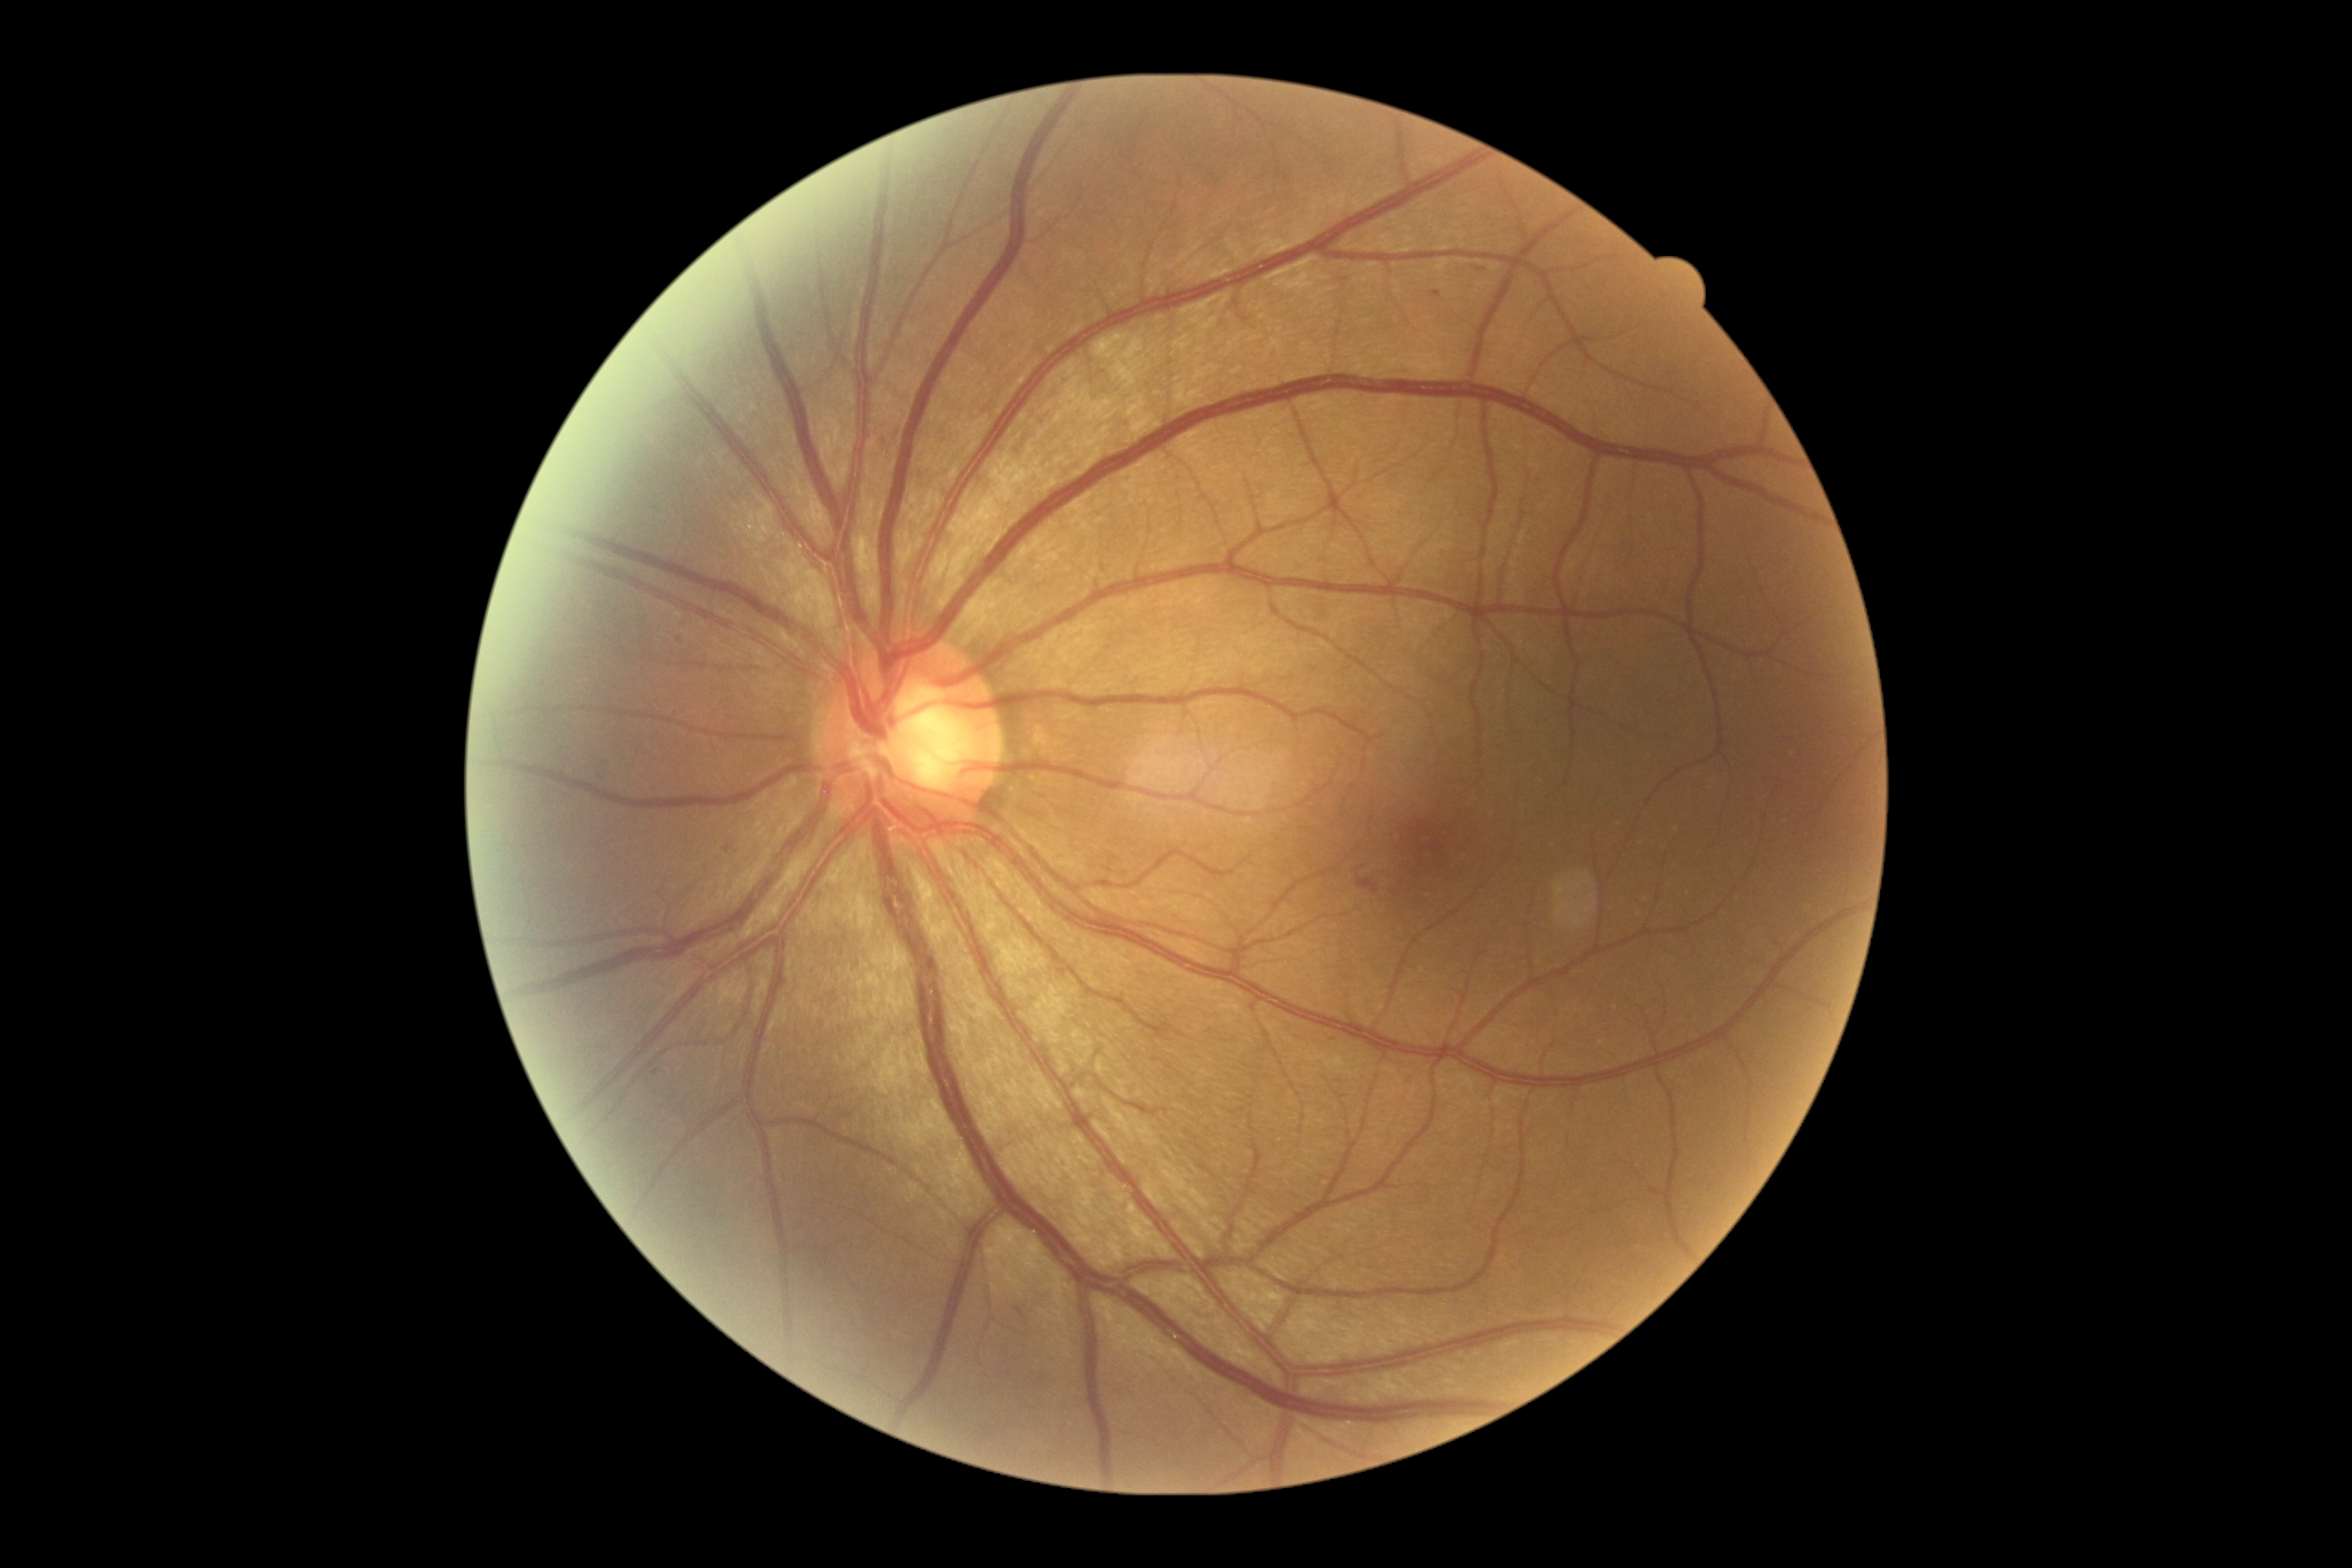

DR class@non-proliferative diabetic retinopathy, diabetic retinopathy (DR)@2.